Color fundus photograph
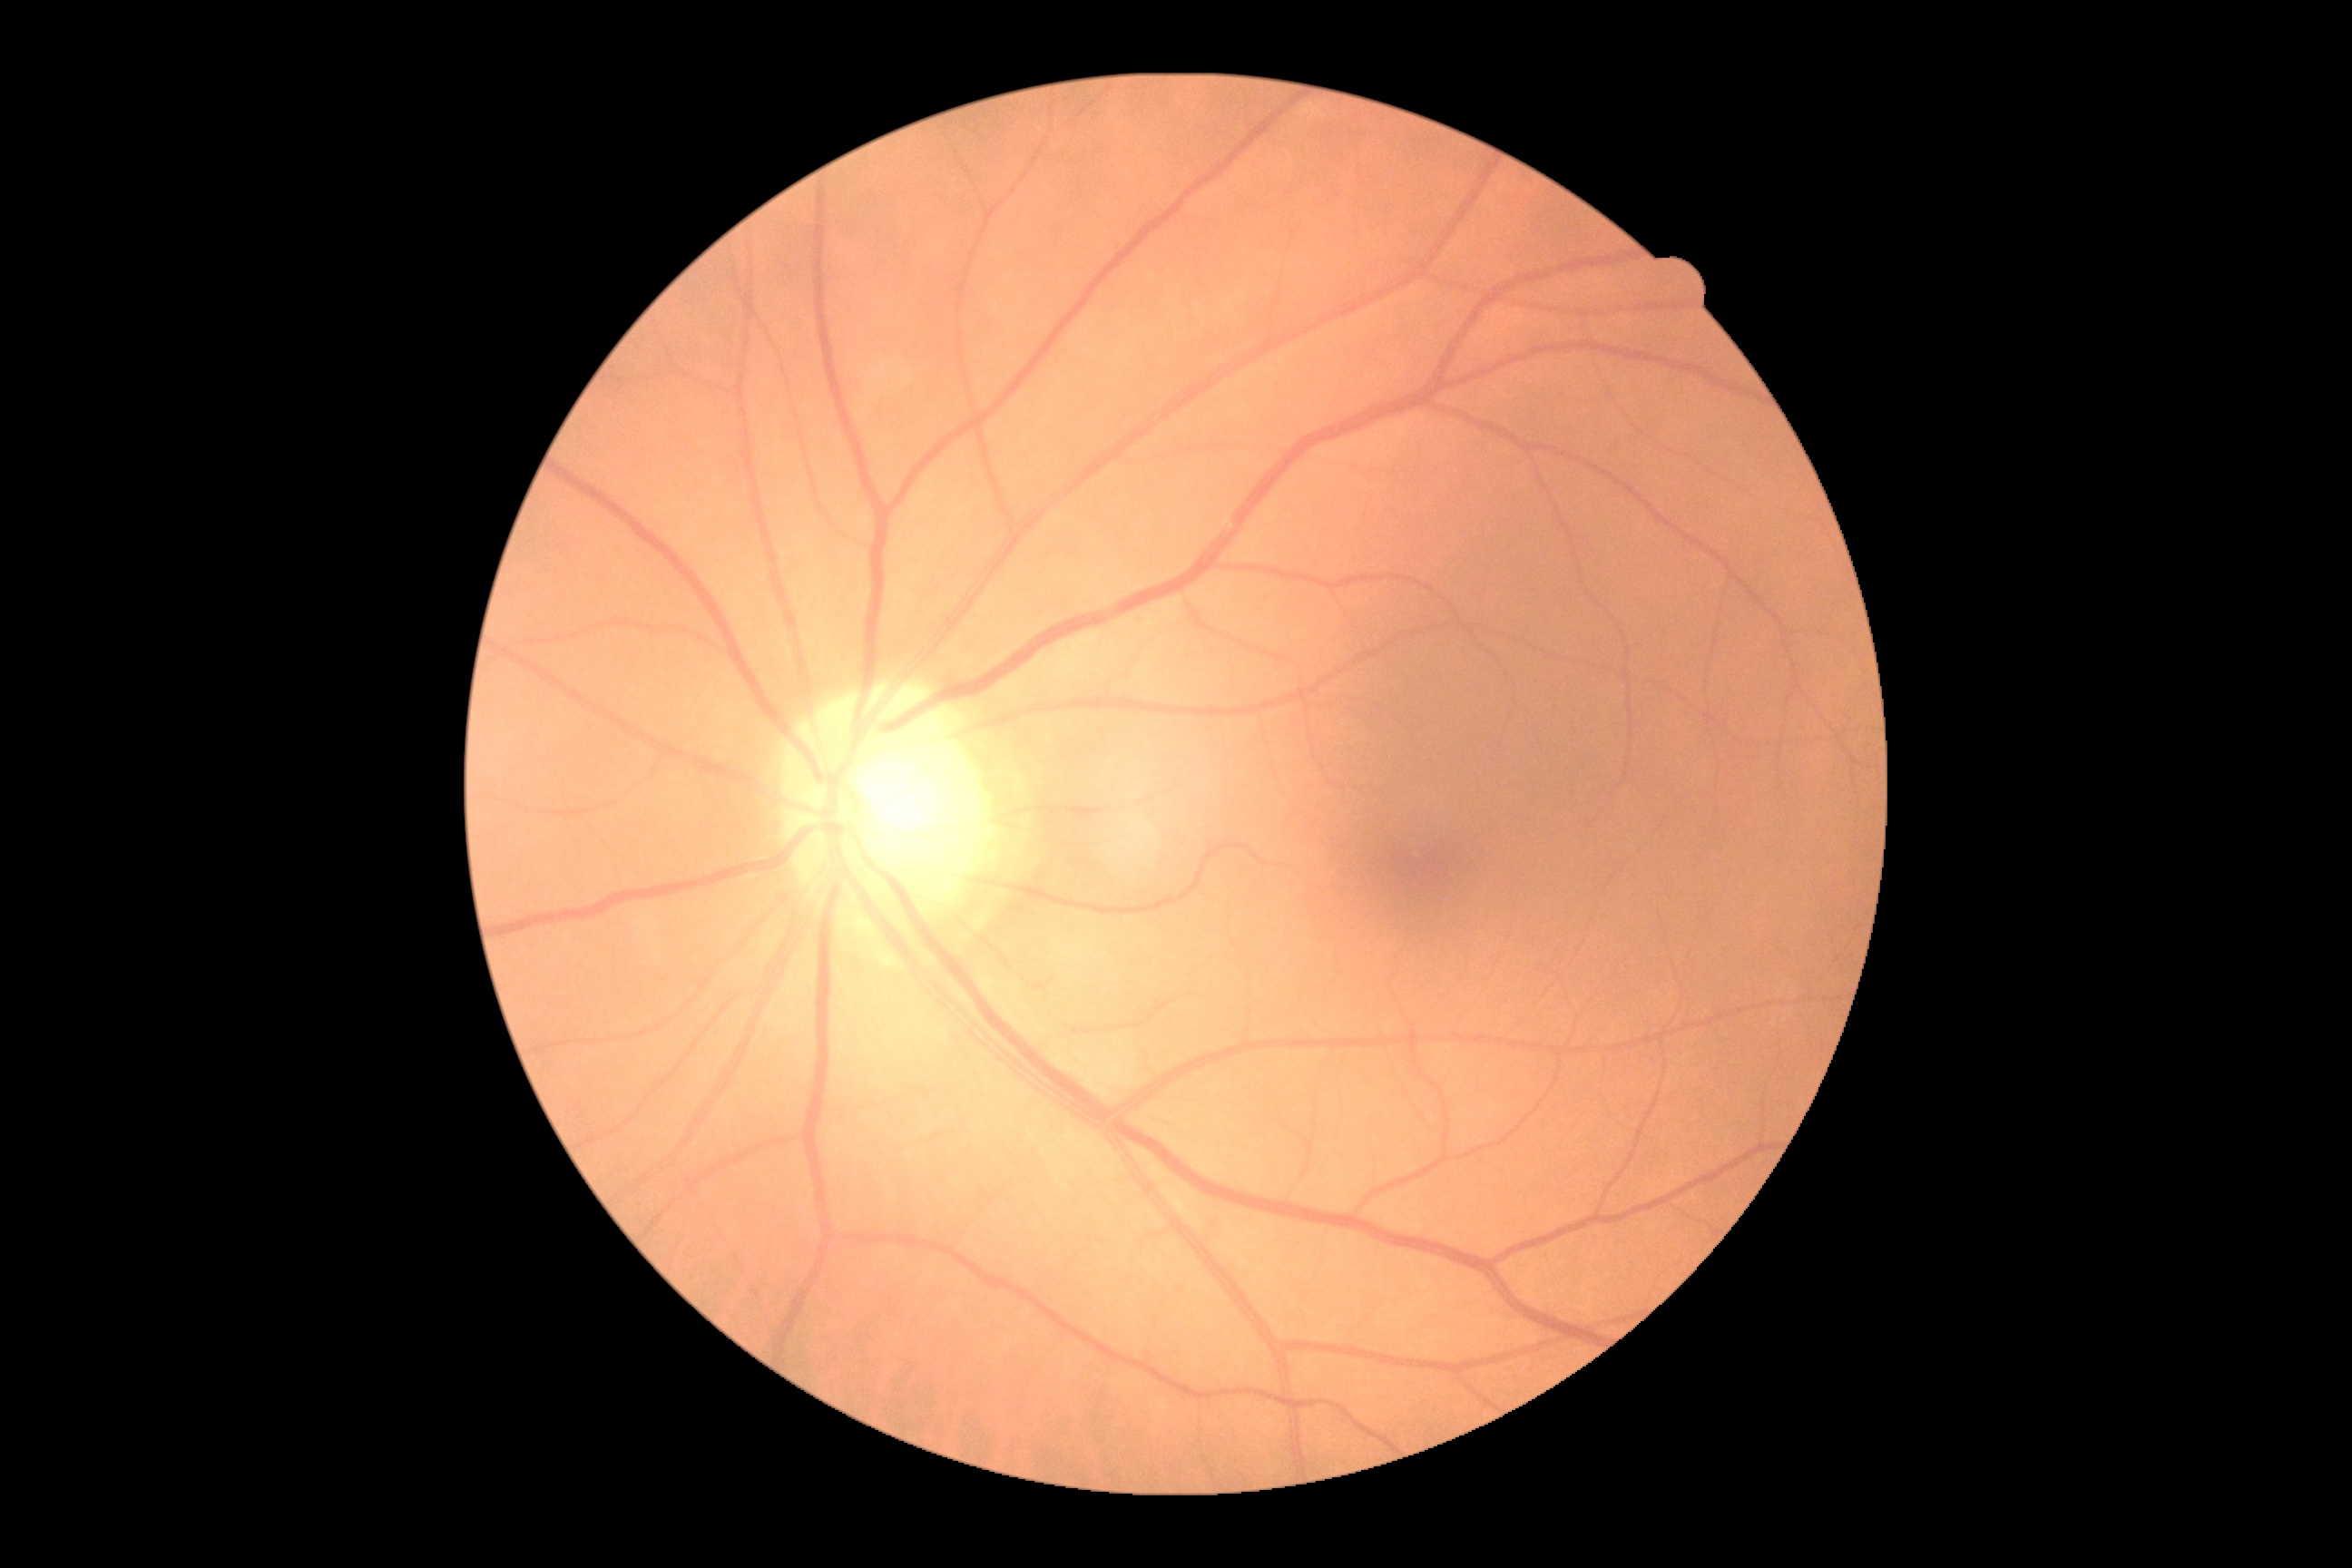

{
  "dr_grade": "no apparent retinopathy (grade 0) — no visible signs of diabetic retinopathy"
}